Portable fundus photograph
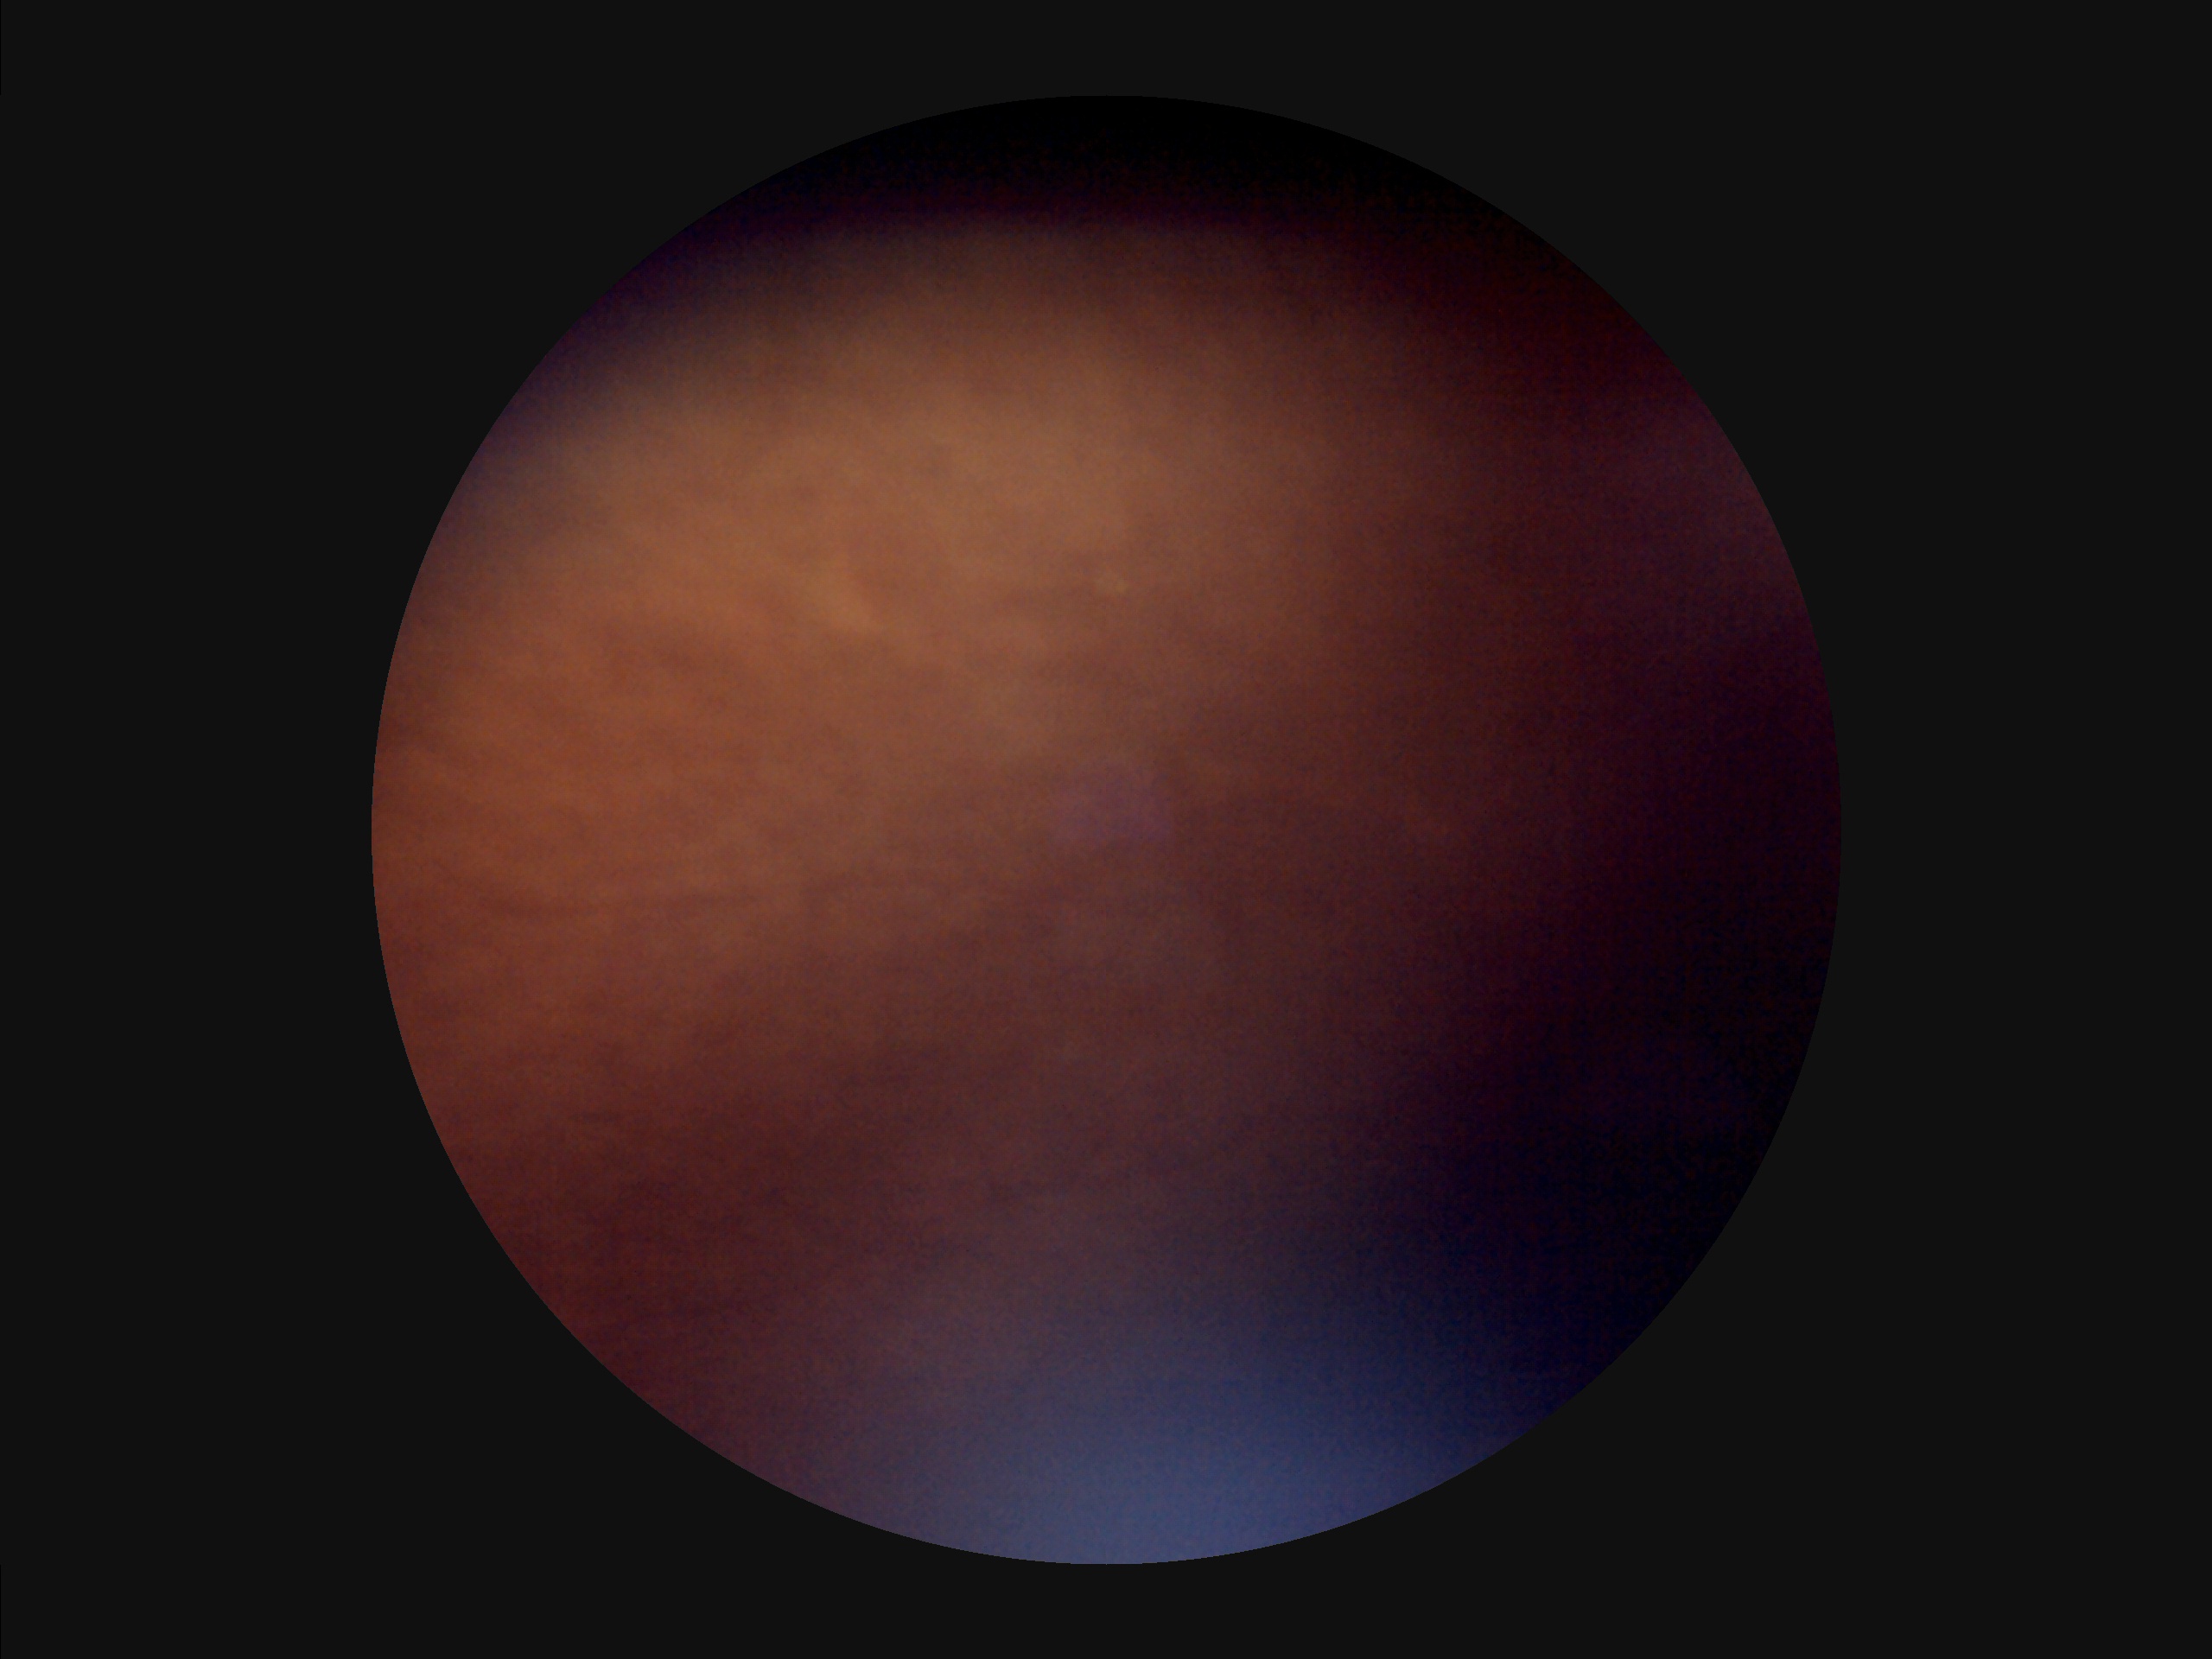
Image quality: clarity: out of focus | illumination/color: poor | contrast: reduced | overall: low.